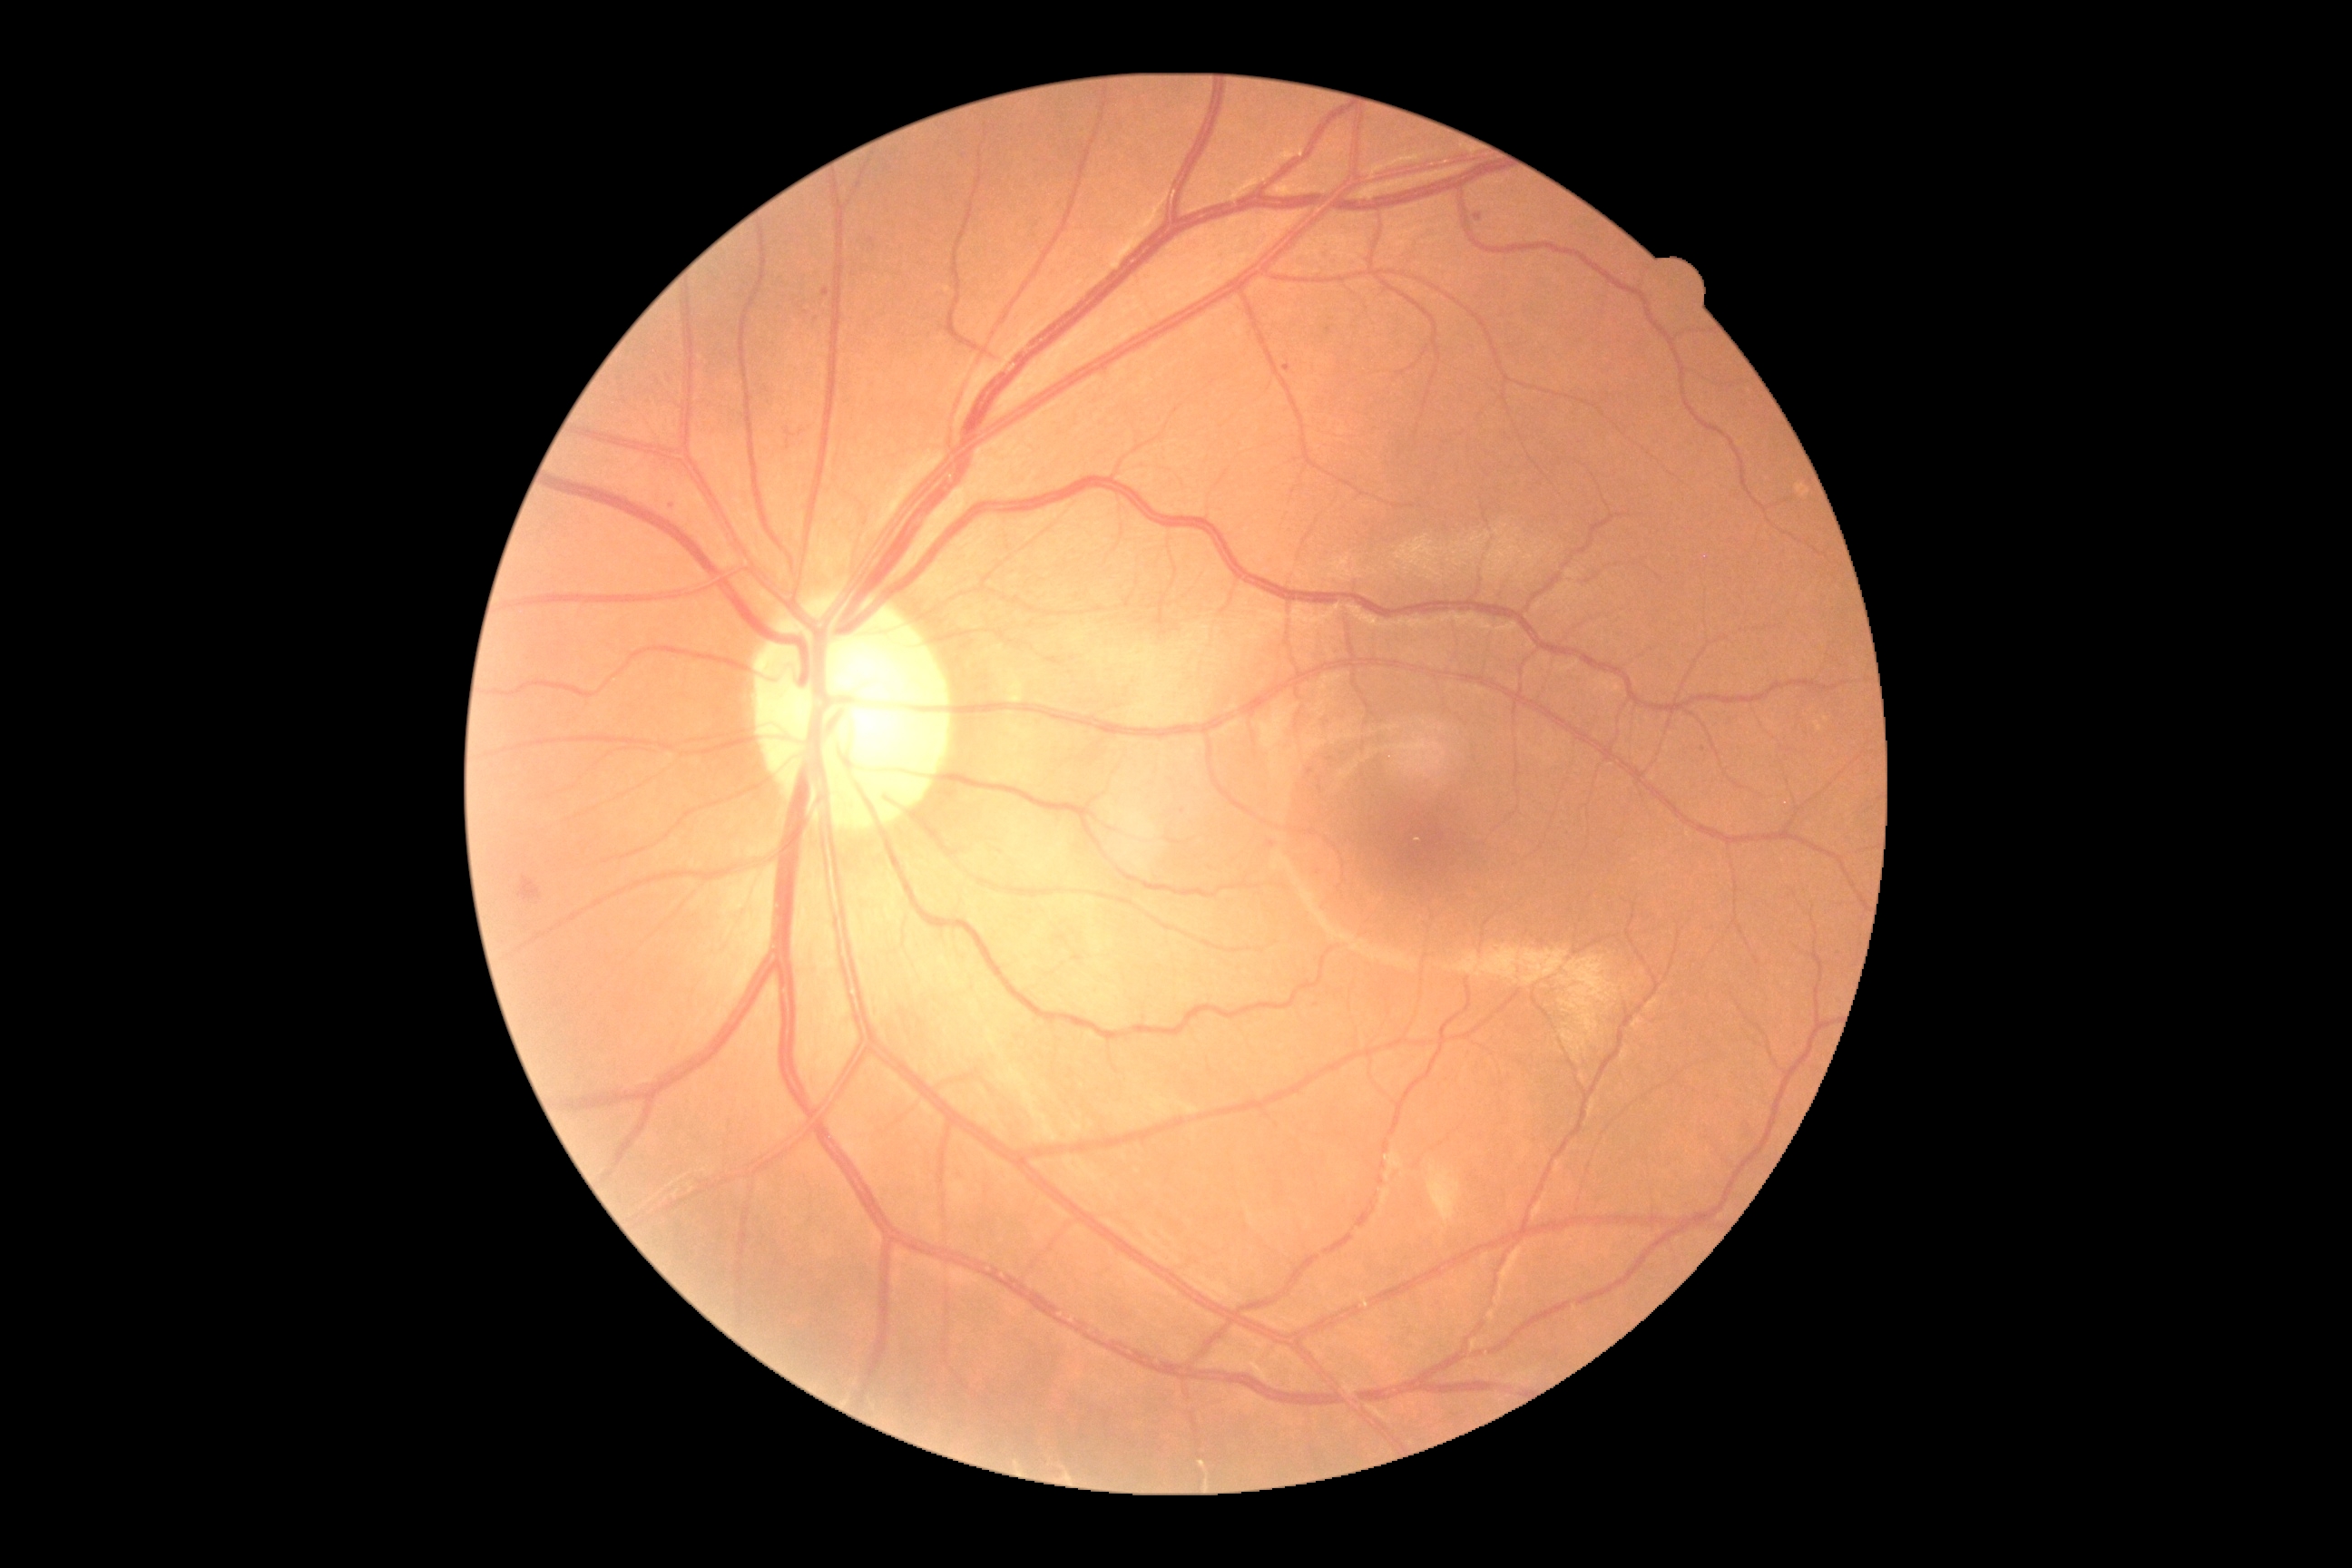
DR stage is 2/4.